130° field of view (Clarity RetCam 3) · wide-field contact fundus photograph of an infant:
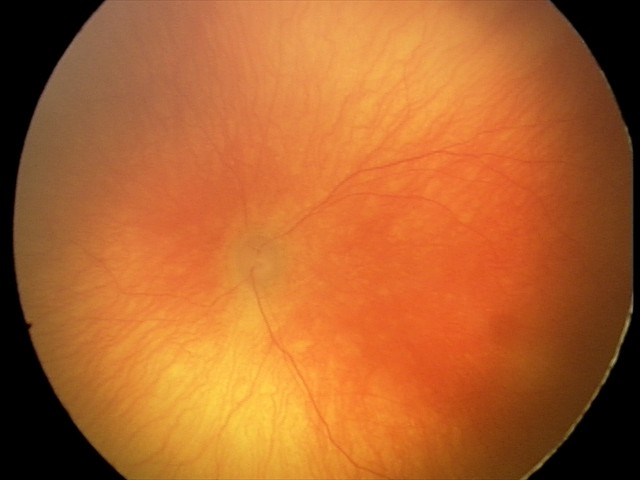

Assessment = aggressive retinopathy of prematurity (A-ROP) — rapidly progressive severe ROP with prominent plus disease, often without classic stage progression.